Image size 1659x2212:
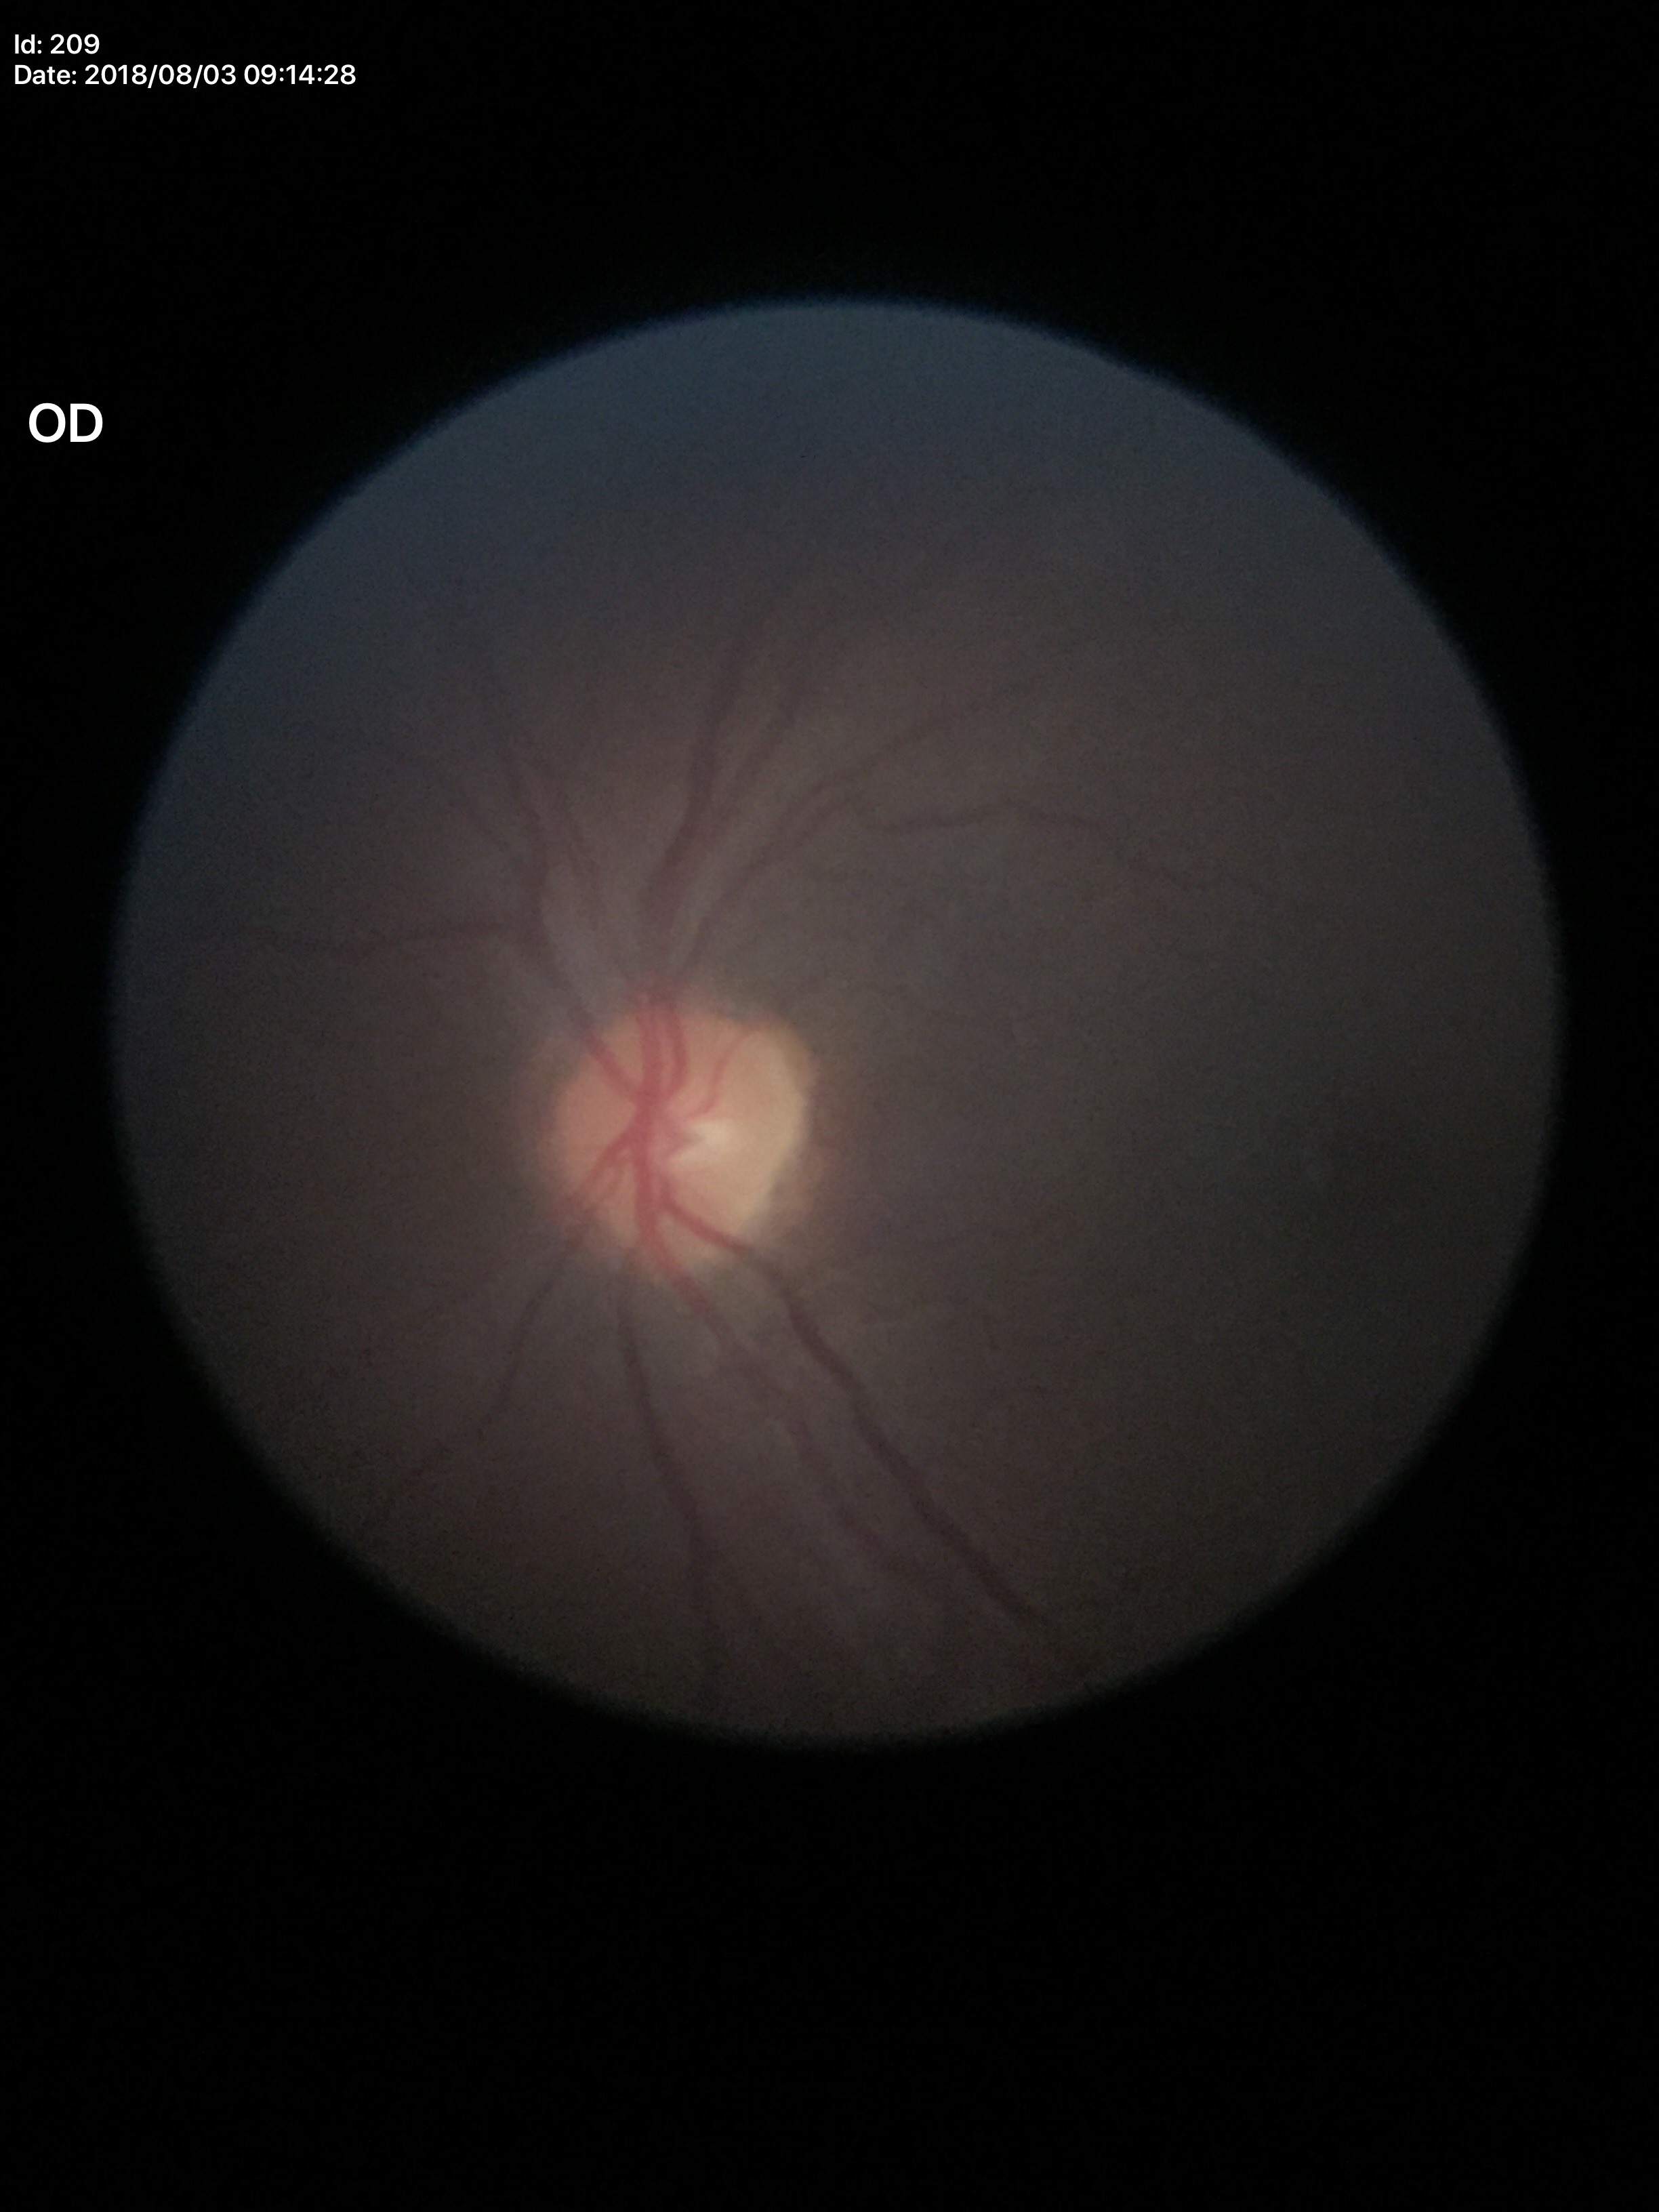

Glaucoma screening: not suspect.
Vertical C/D ratio is 0.29.
Horizontal cup-to-disc ratio: 0.37.